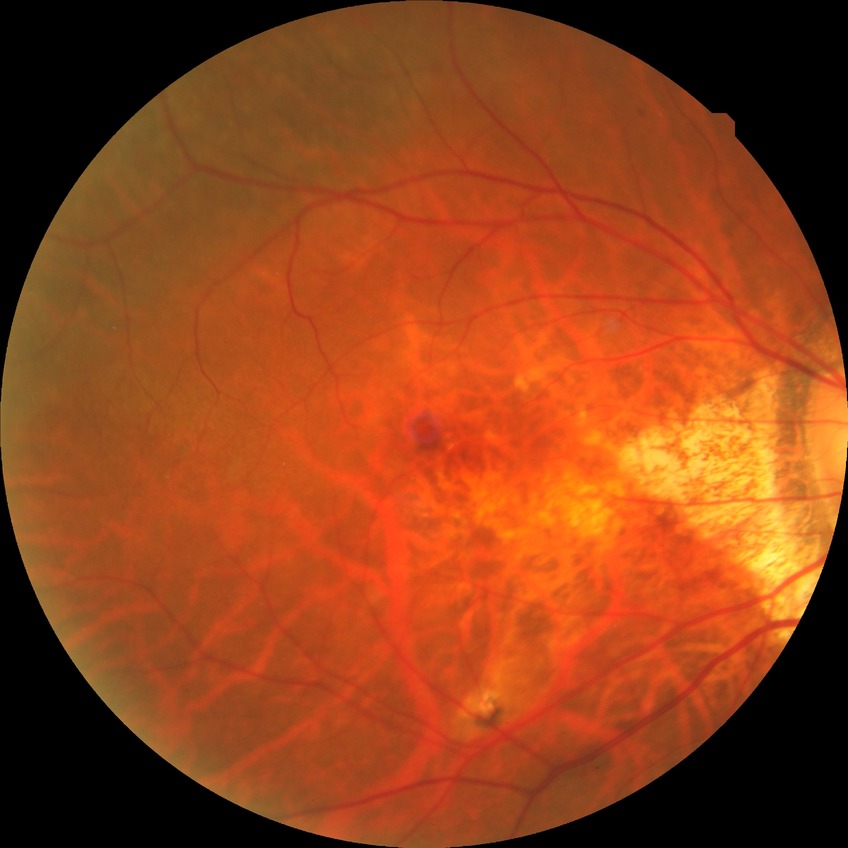

diabetic retinopathy severity: no diabetic retinopathy.